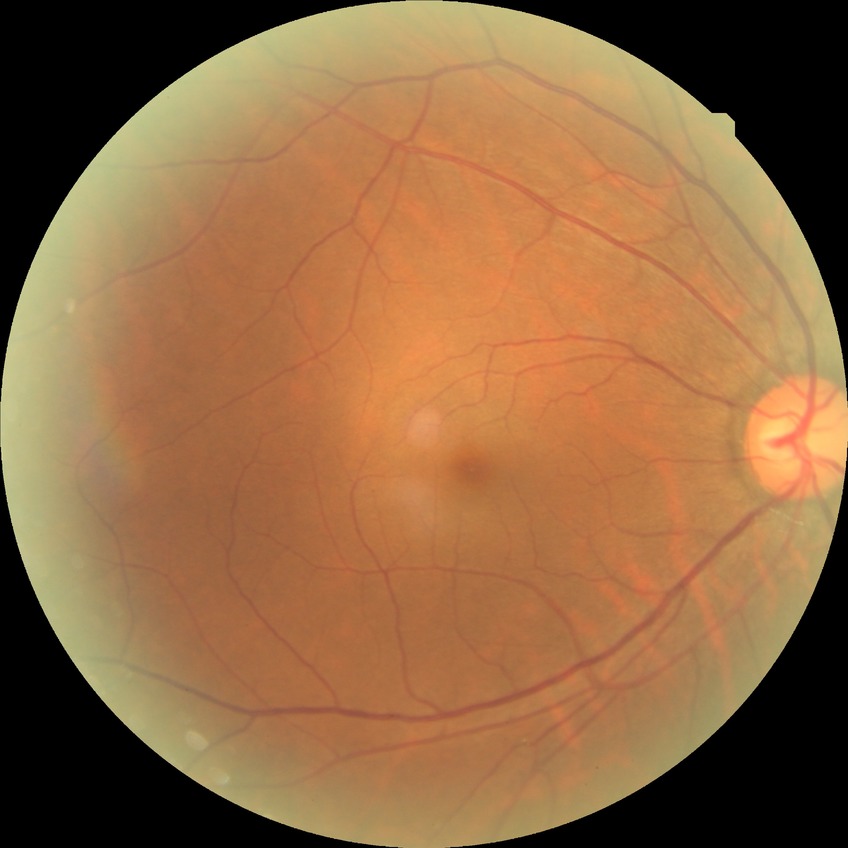 diabetic retinopathy (DR)=NDR (no diabetic retinopathy).